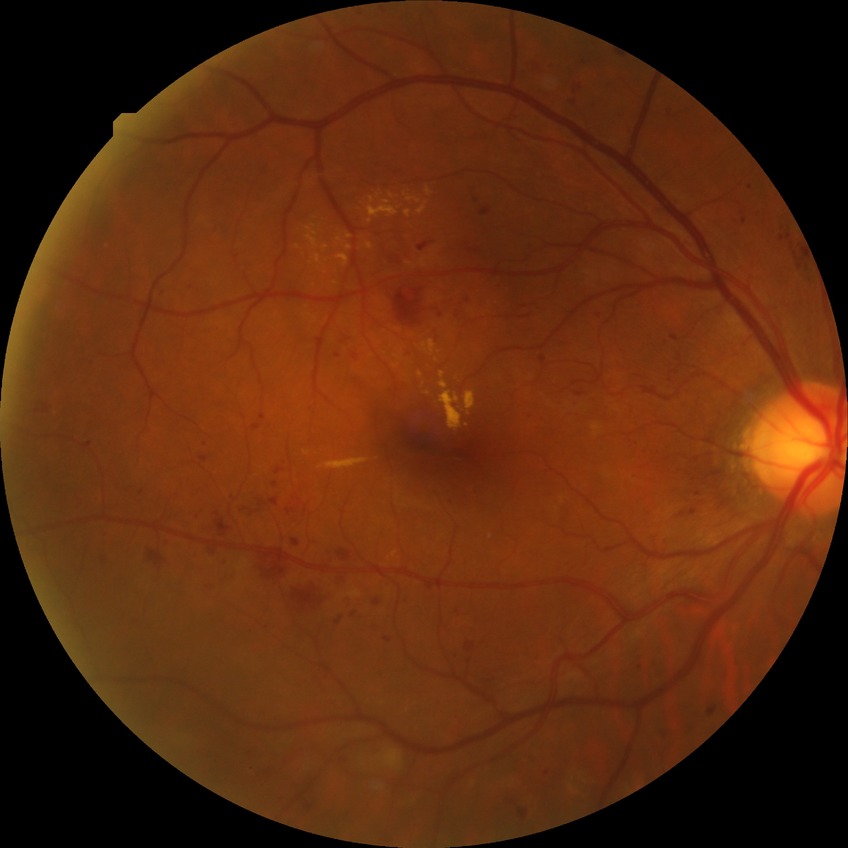

diabetic retinopathy (DR): pre-proliferative diabetic retinopathy (PPDR).